848x848px. 45 degree fundus photograph. Camera: NIDEK AFC-230: 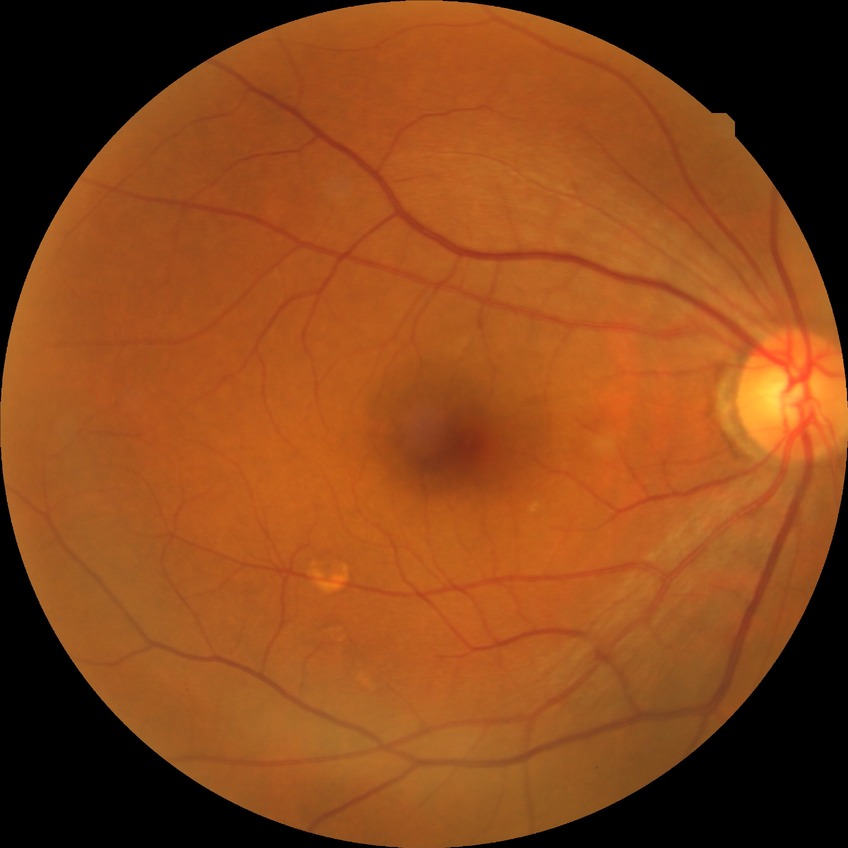
Diabetic retinopathy (DR) is NDR (no diabetic retinopathy).